Retinal fundus photograph.
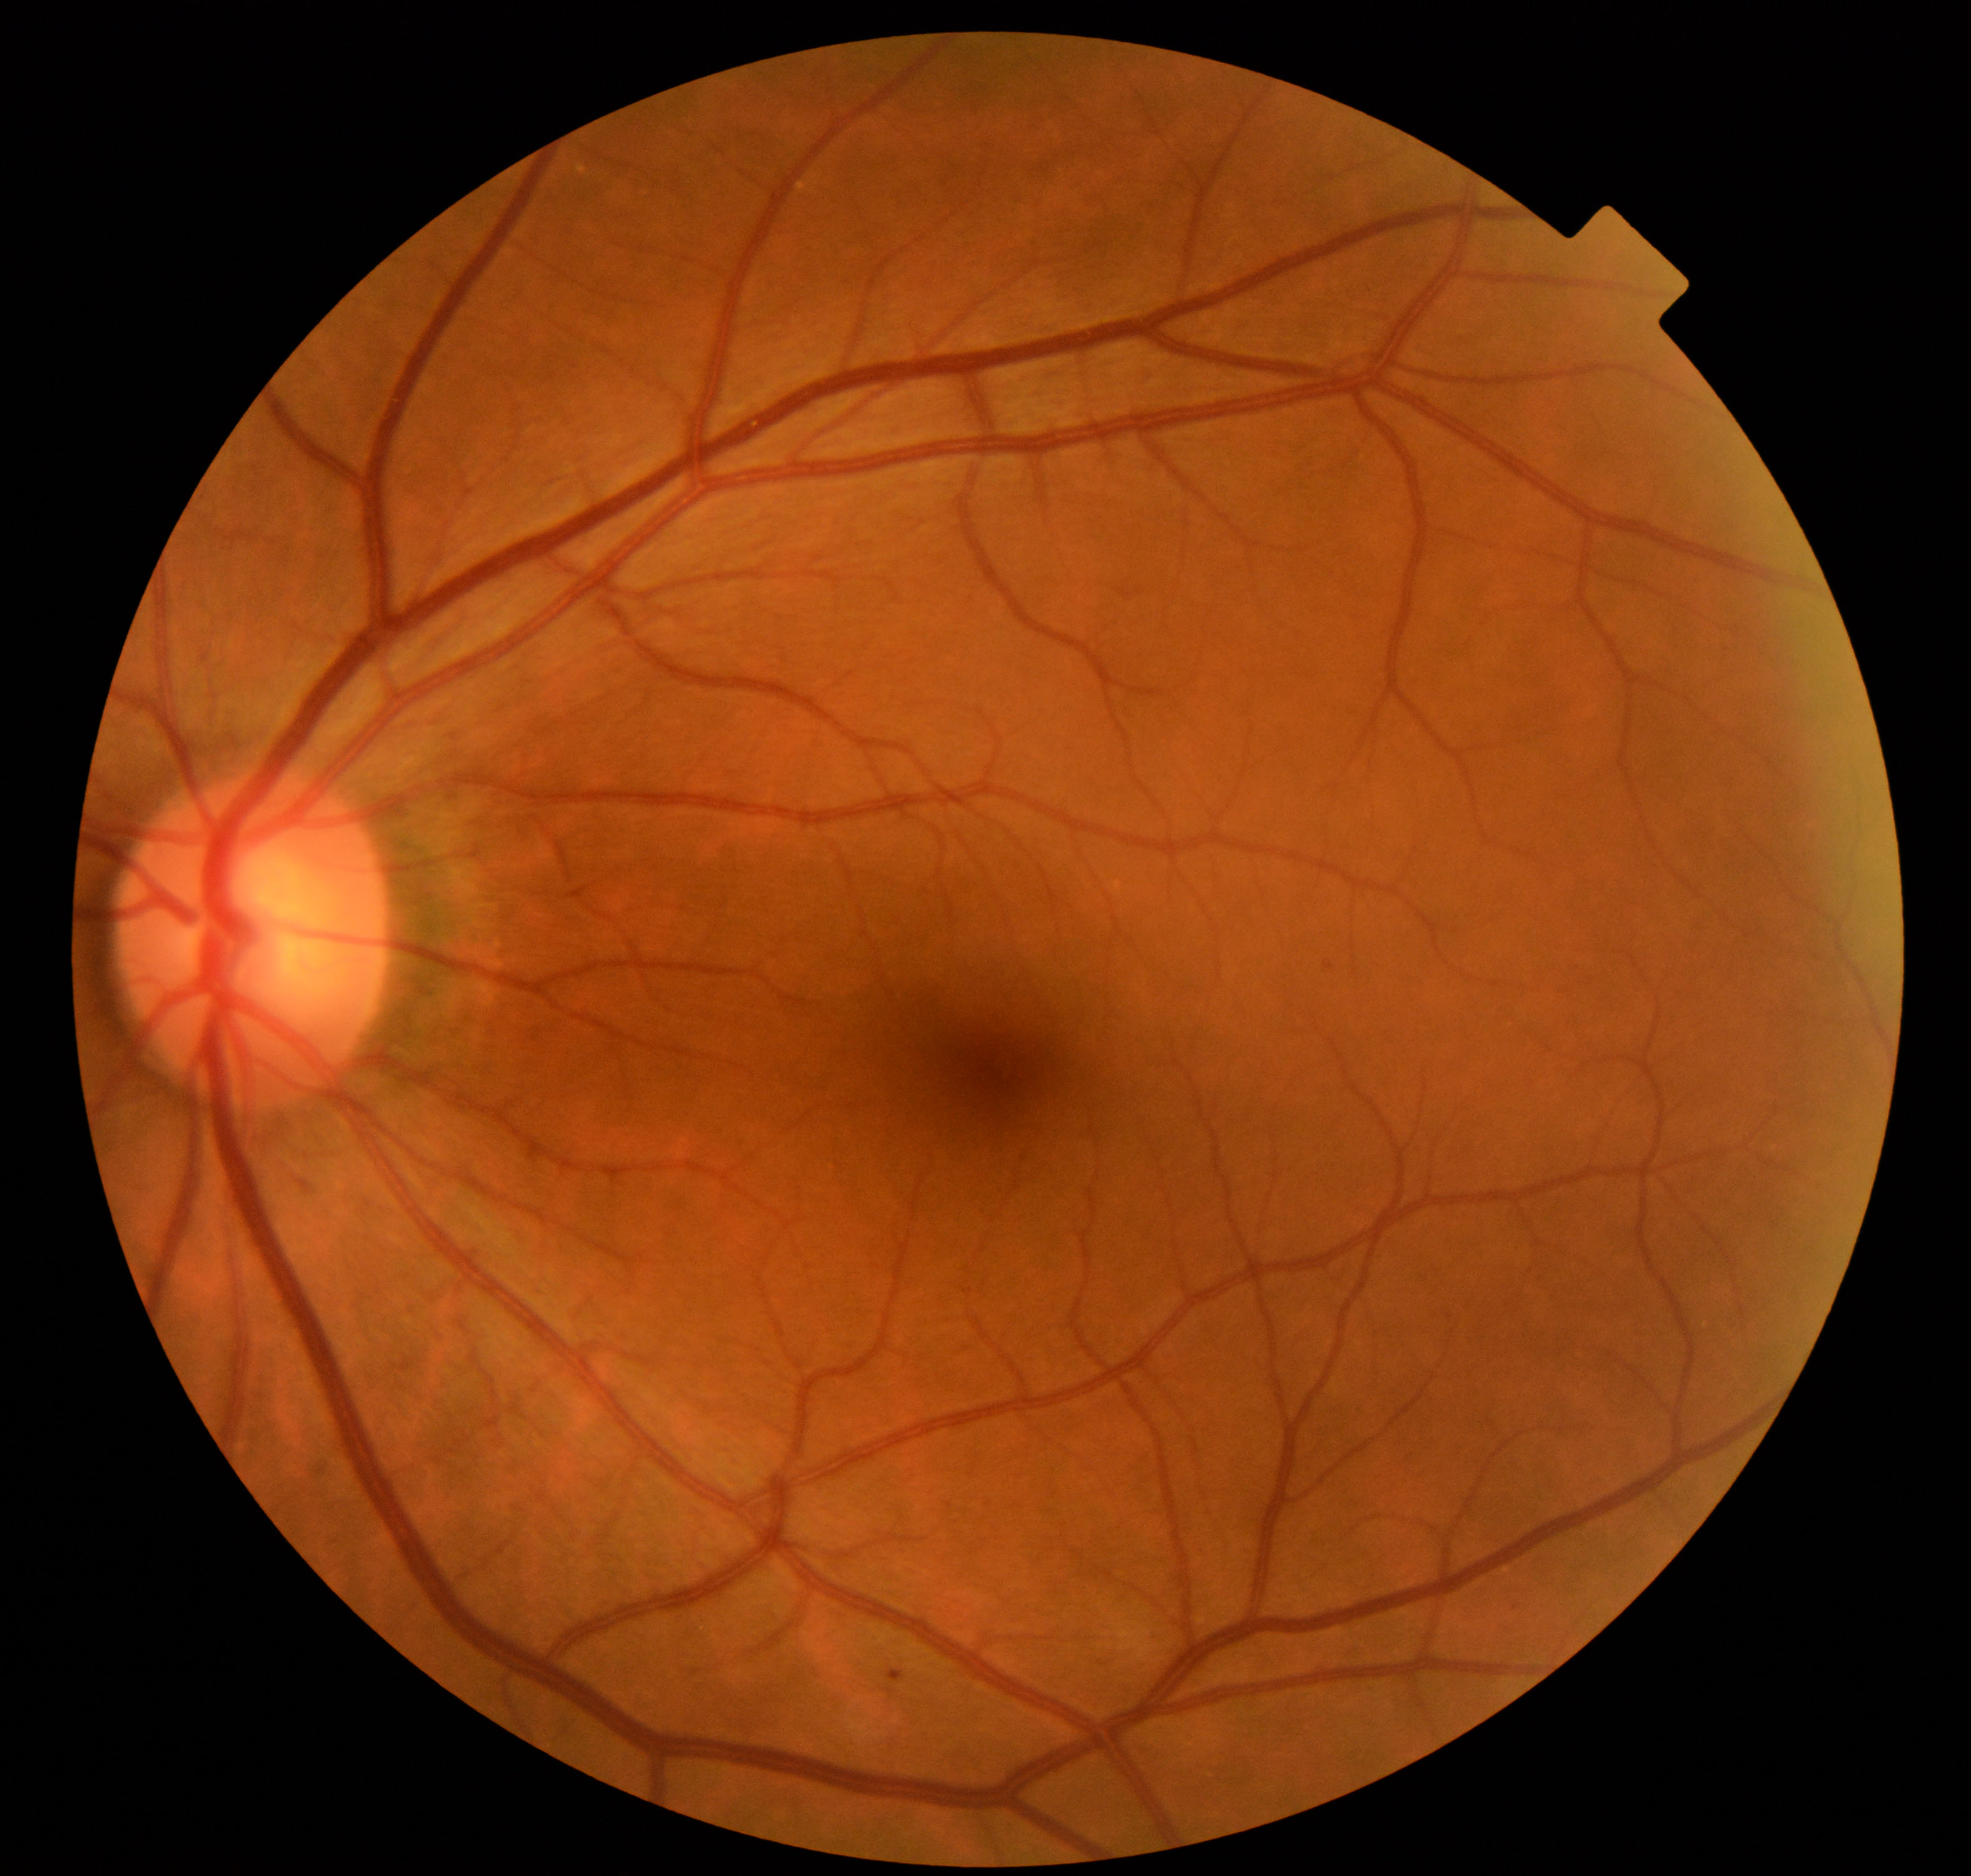
Impression: mild non-proliferative diabetic retinopathy.